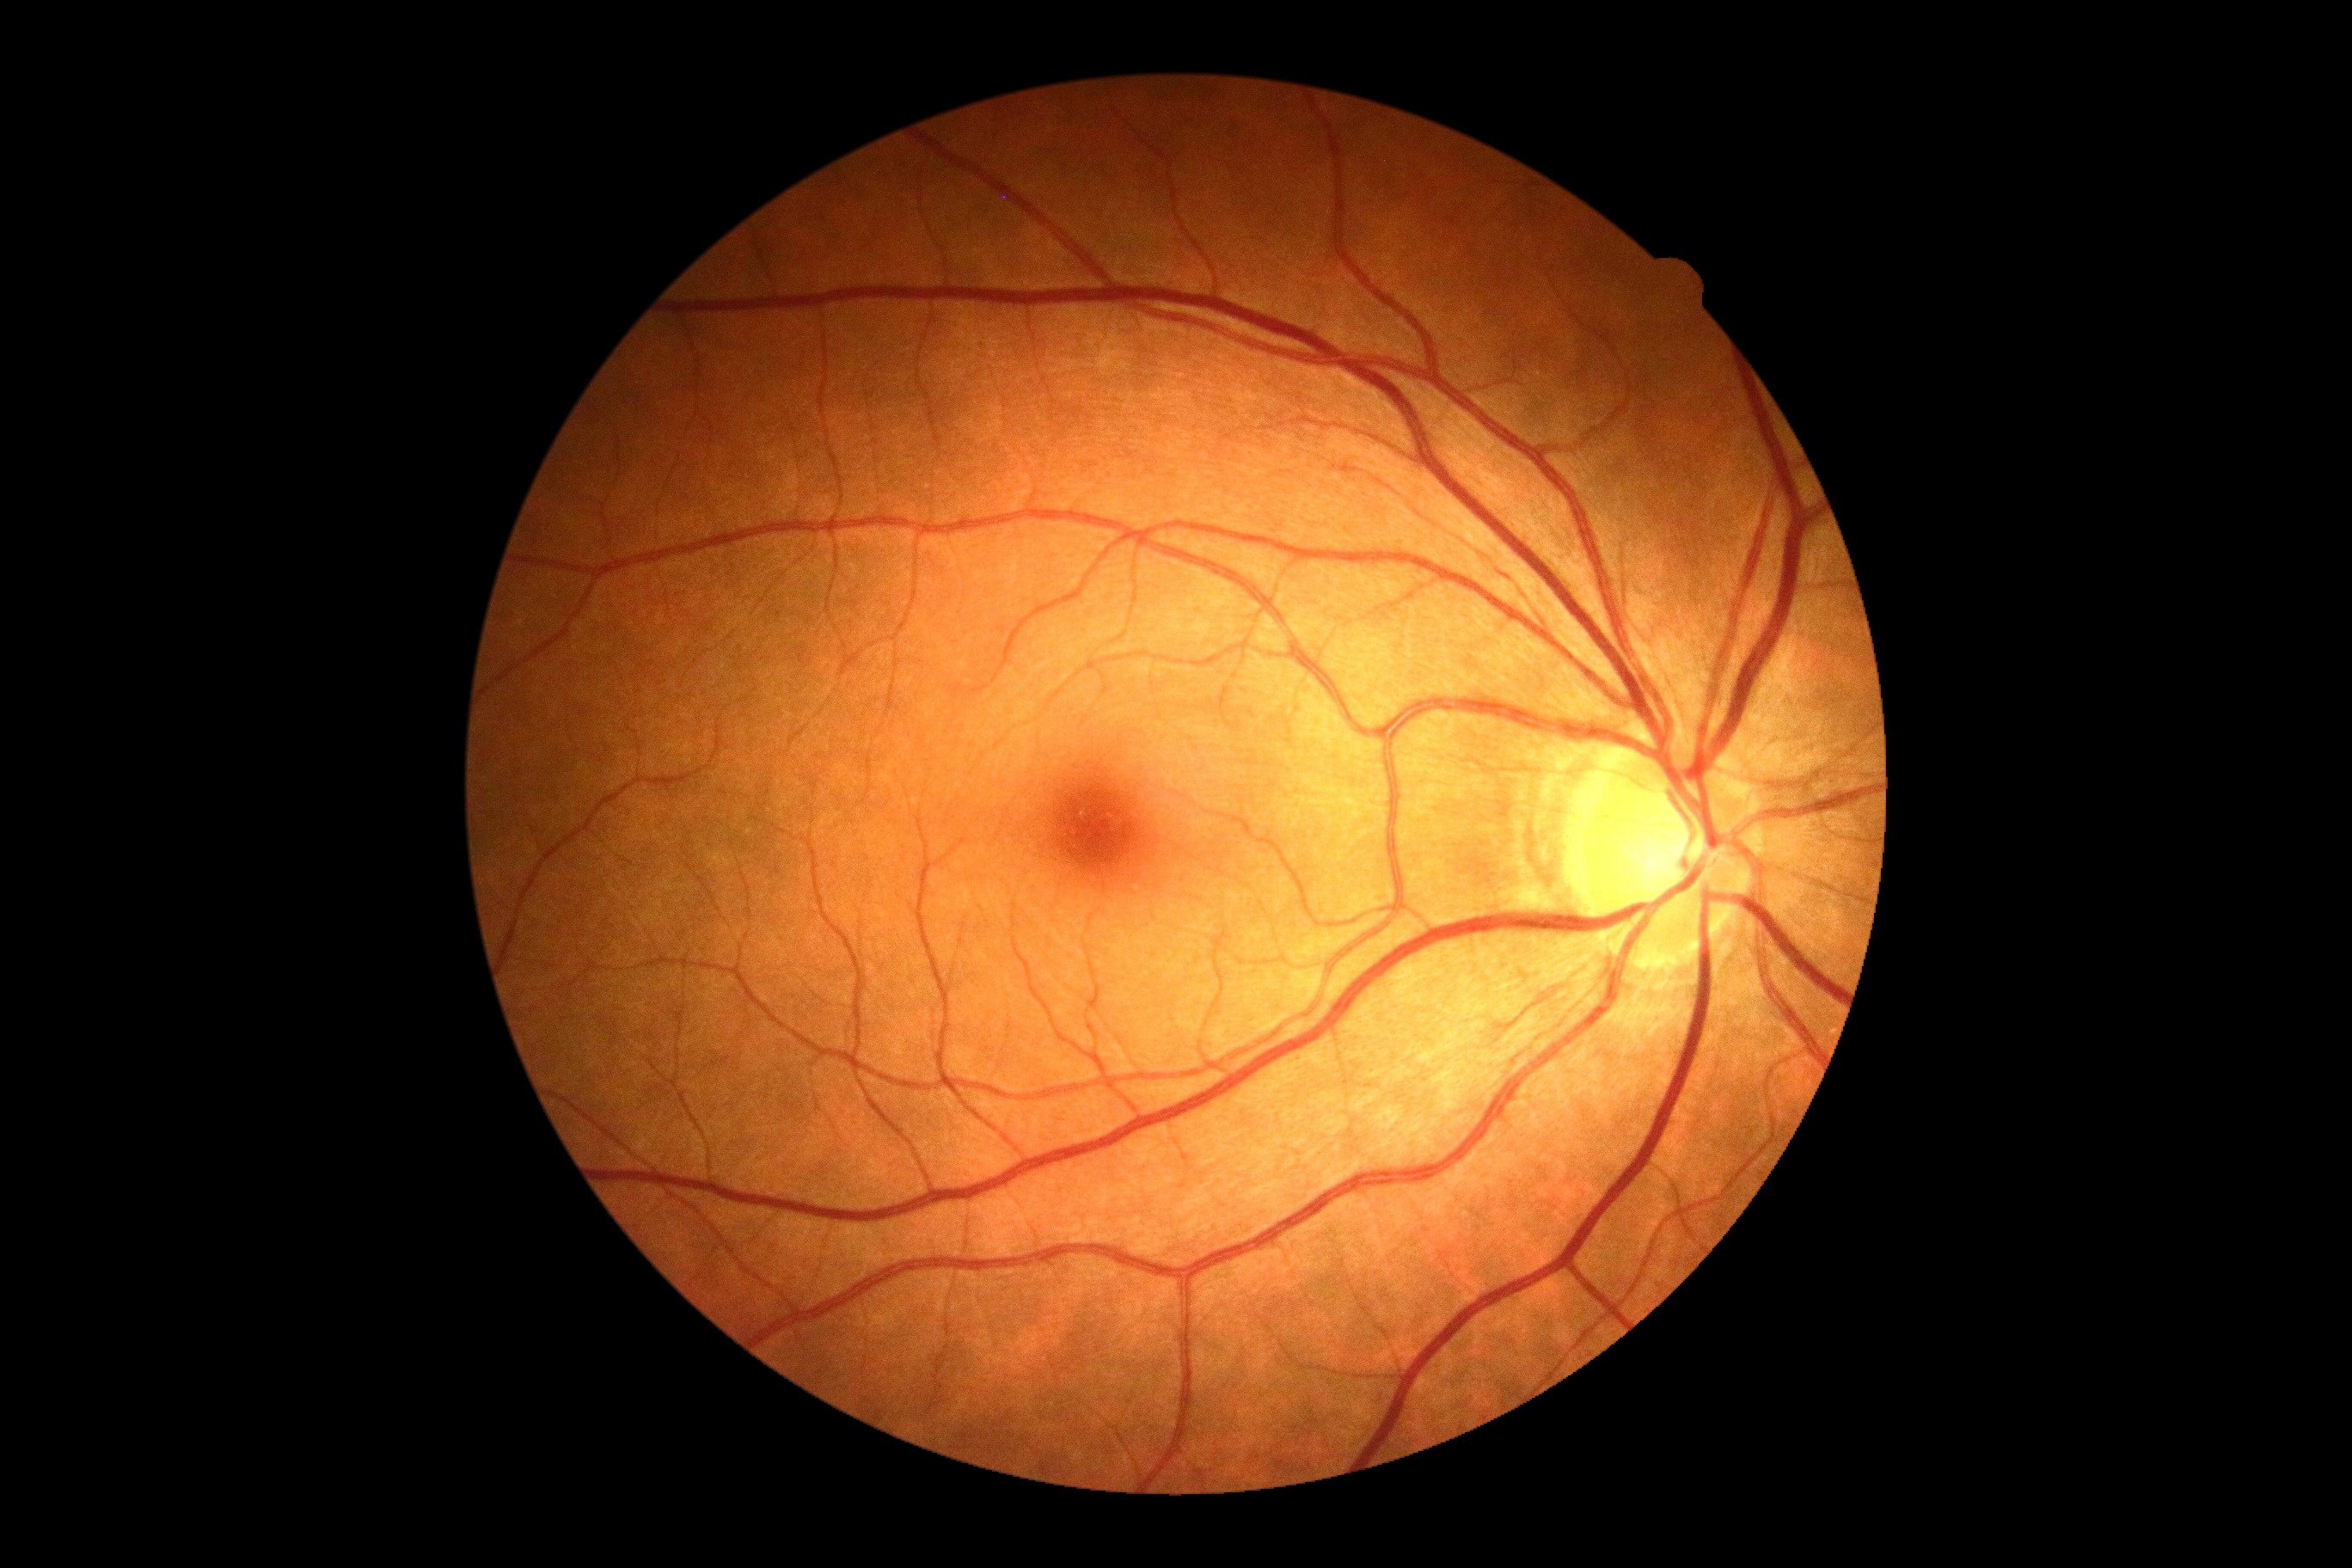
- DR grade: no apparent diabetic retinopathy (0)